Captured with the Phoenix ICON (100° field of view) · wide-field fundus image from infant ROP screening — 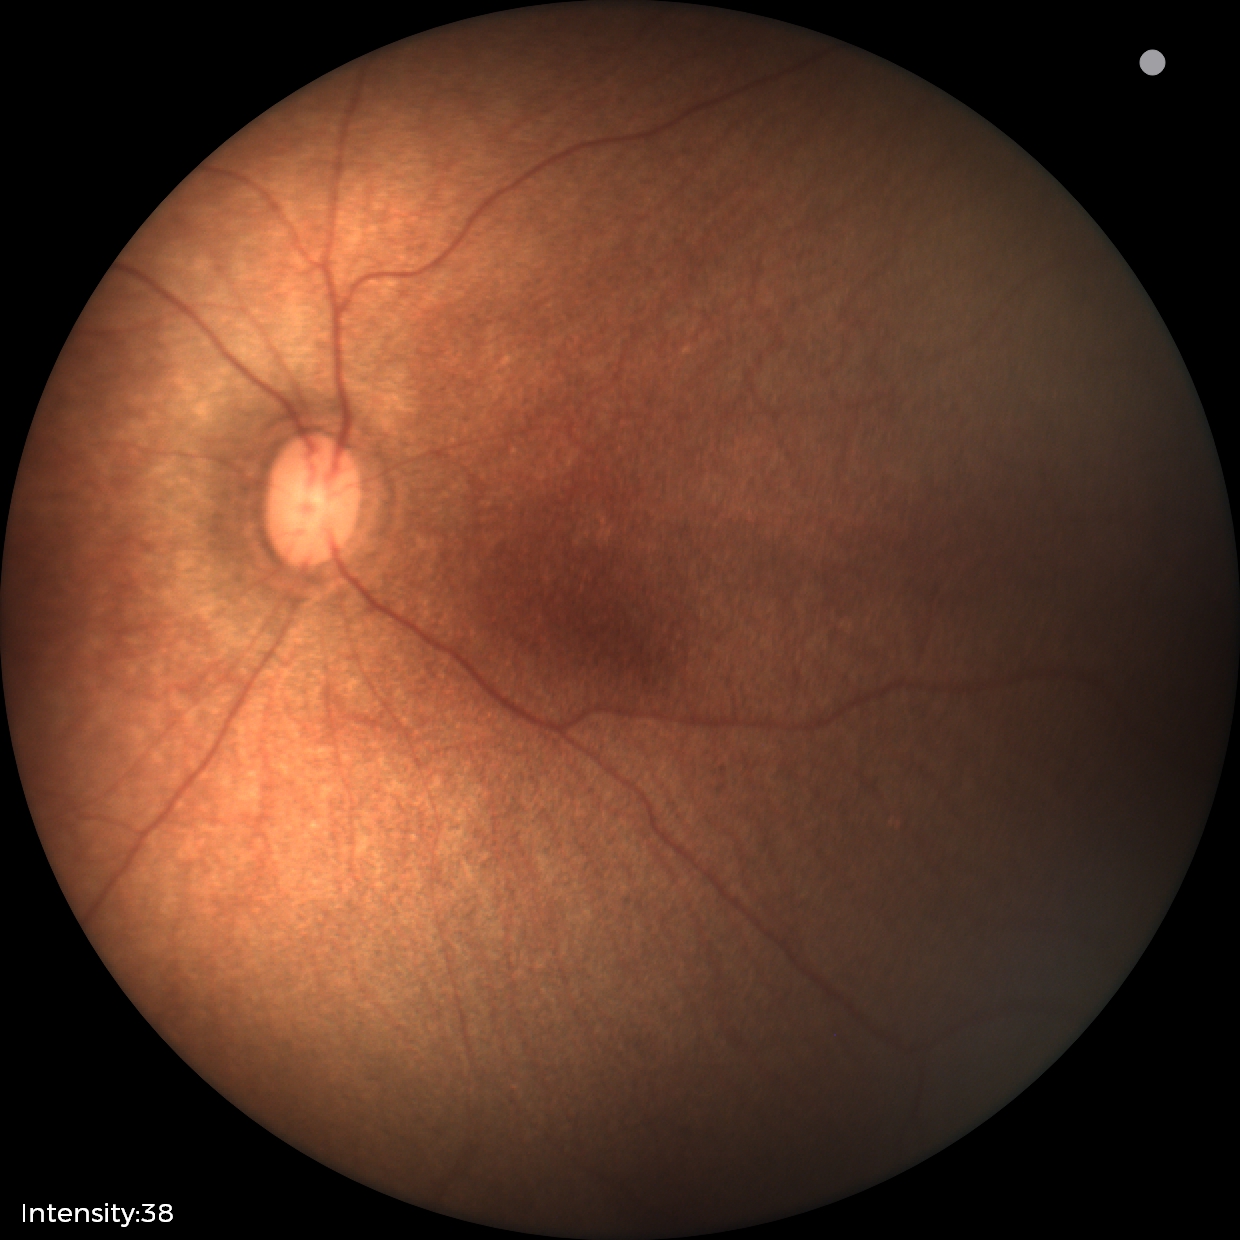
Physiological retinal appearance for postconceptual age.